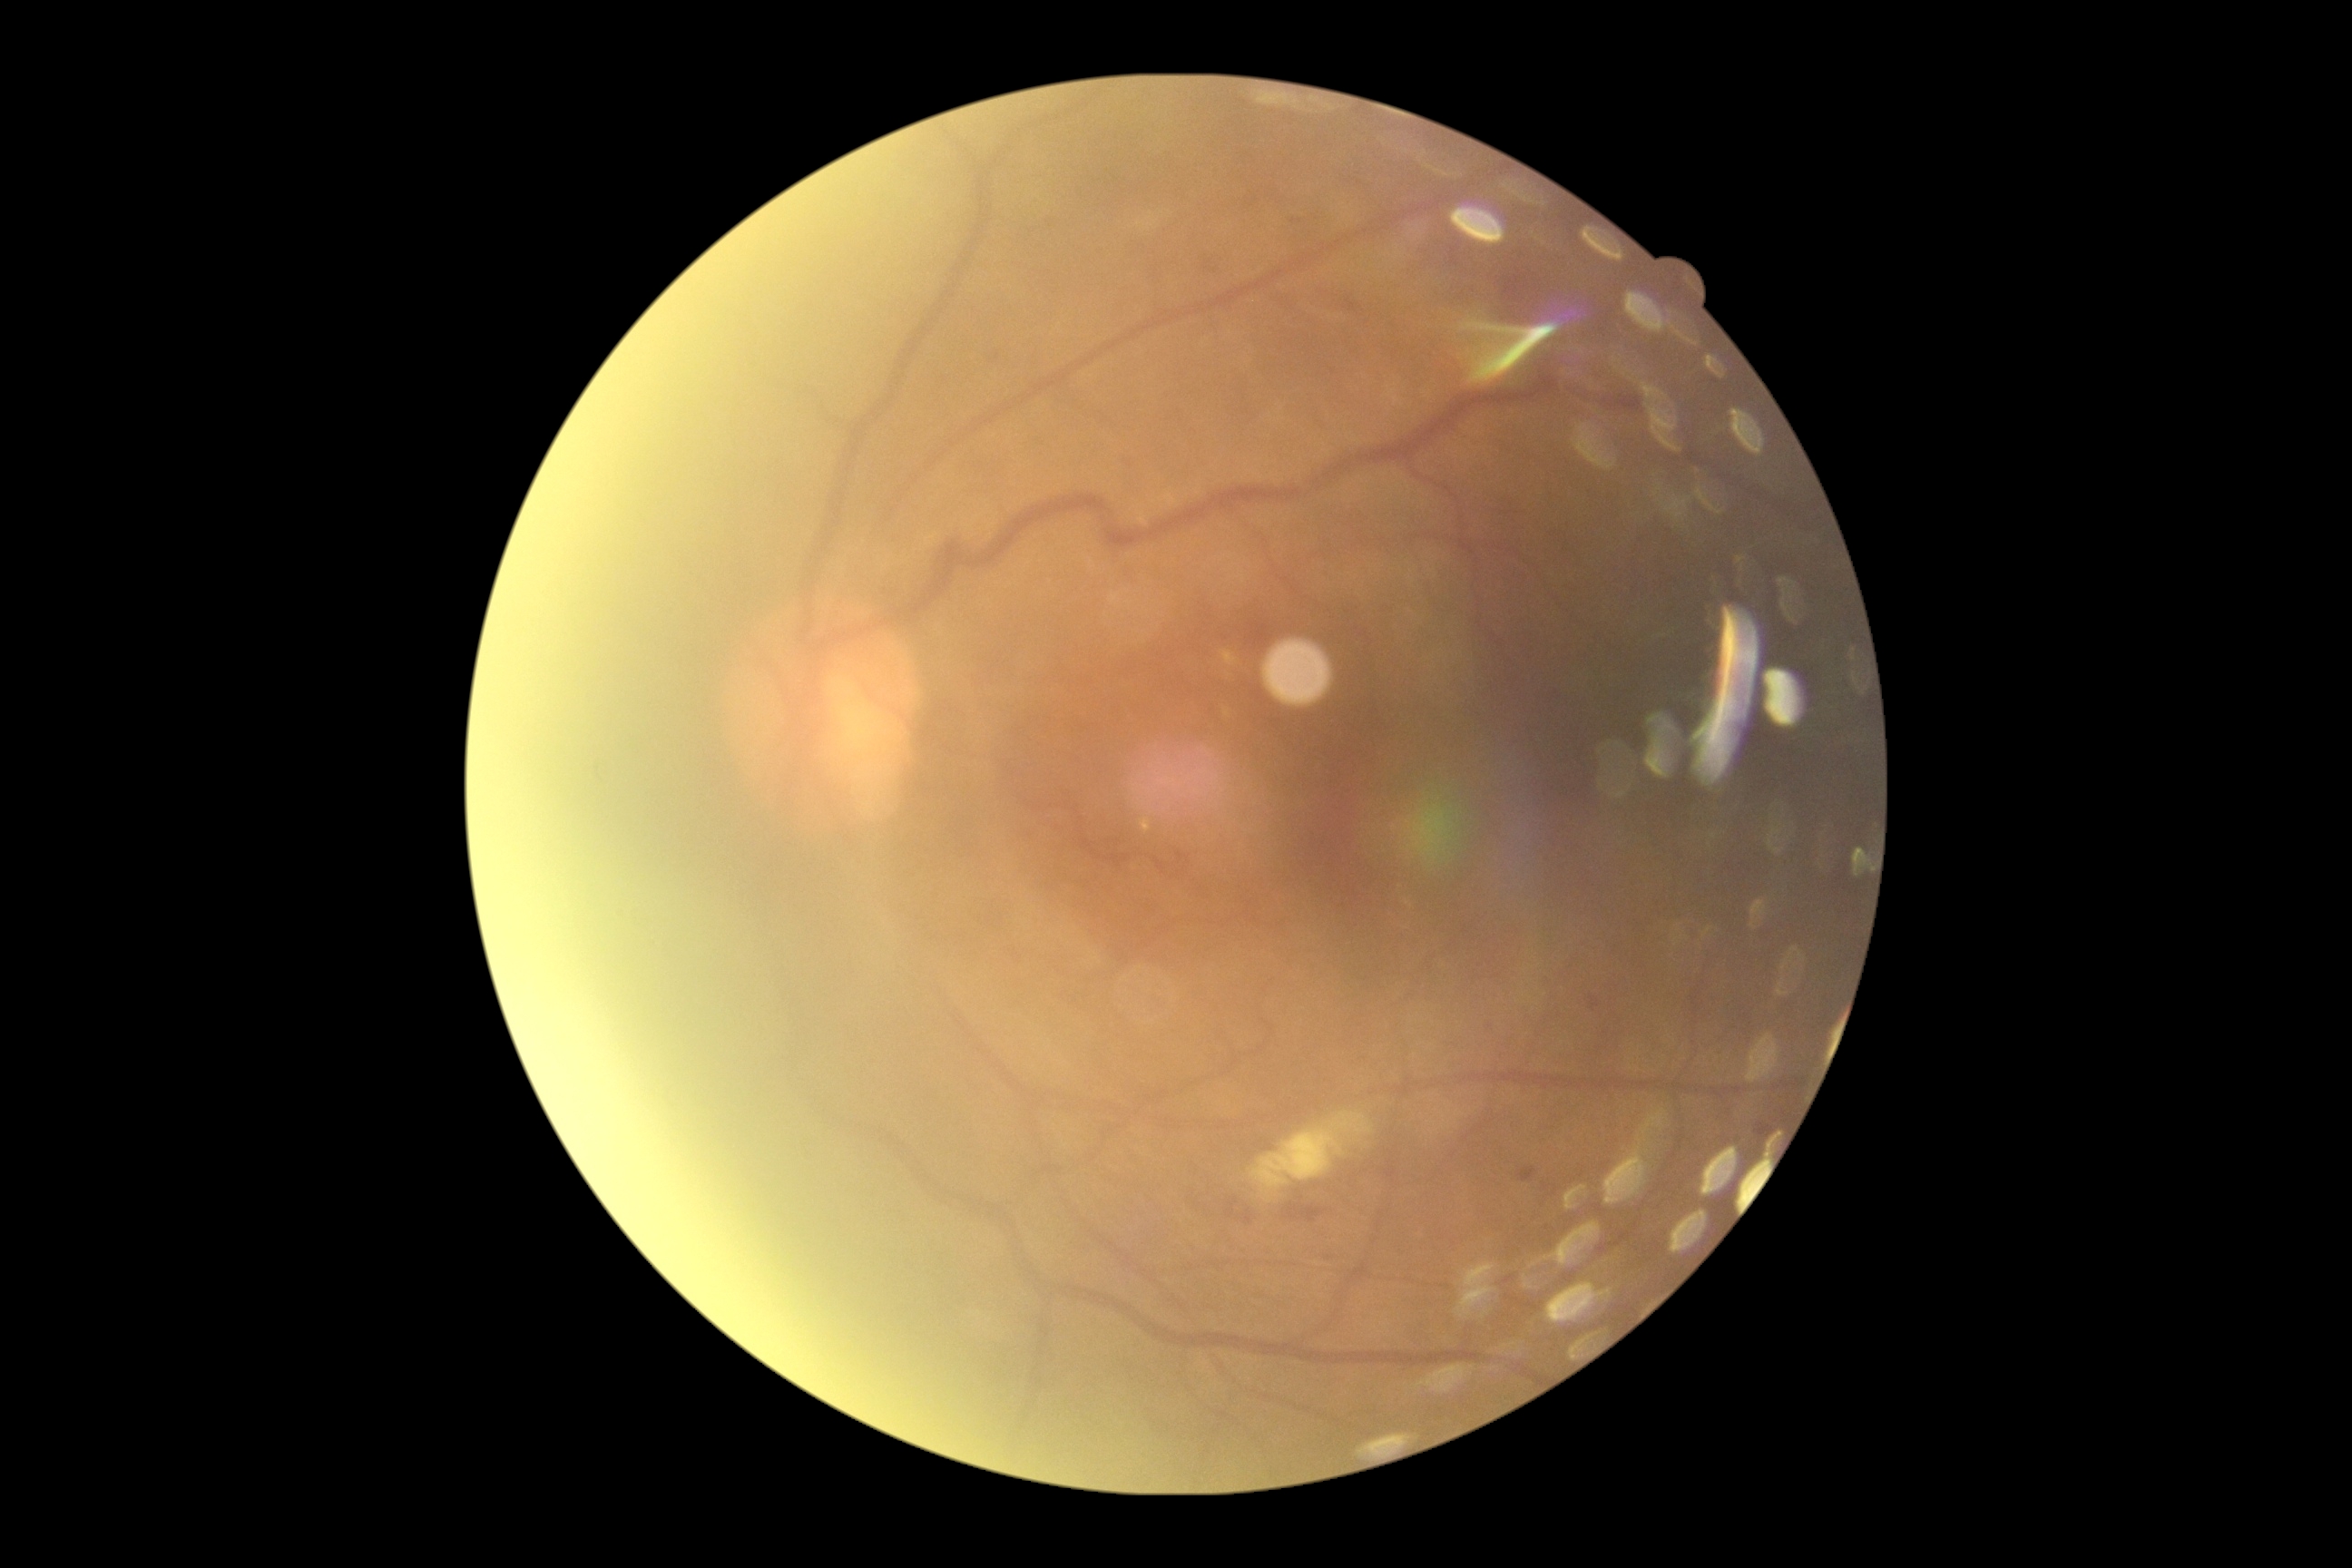

diabetic retinopathy: grade 2 (moderate NPDR) — more than just microaneurysms but less than severe NPDR, DR class: non-proliferative diabetic retinopathy.